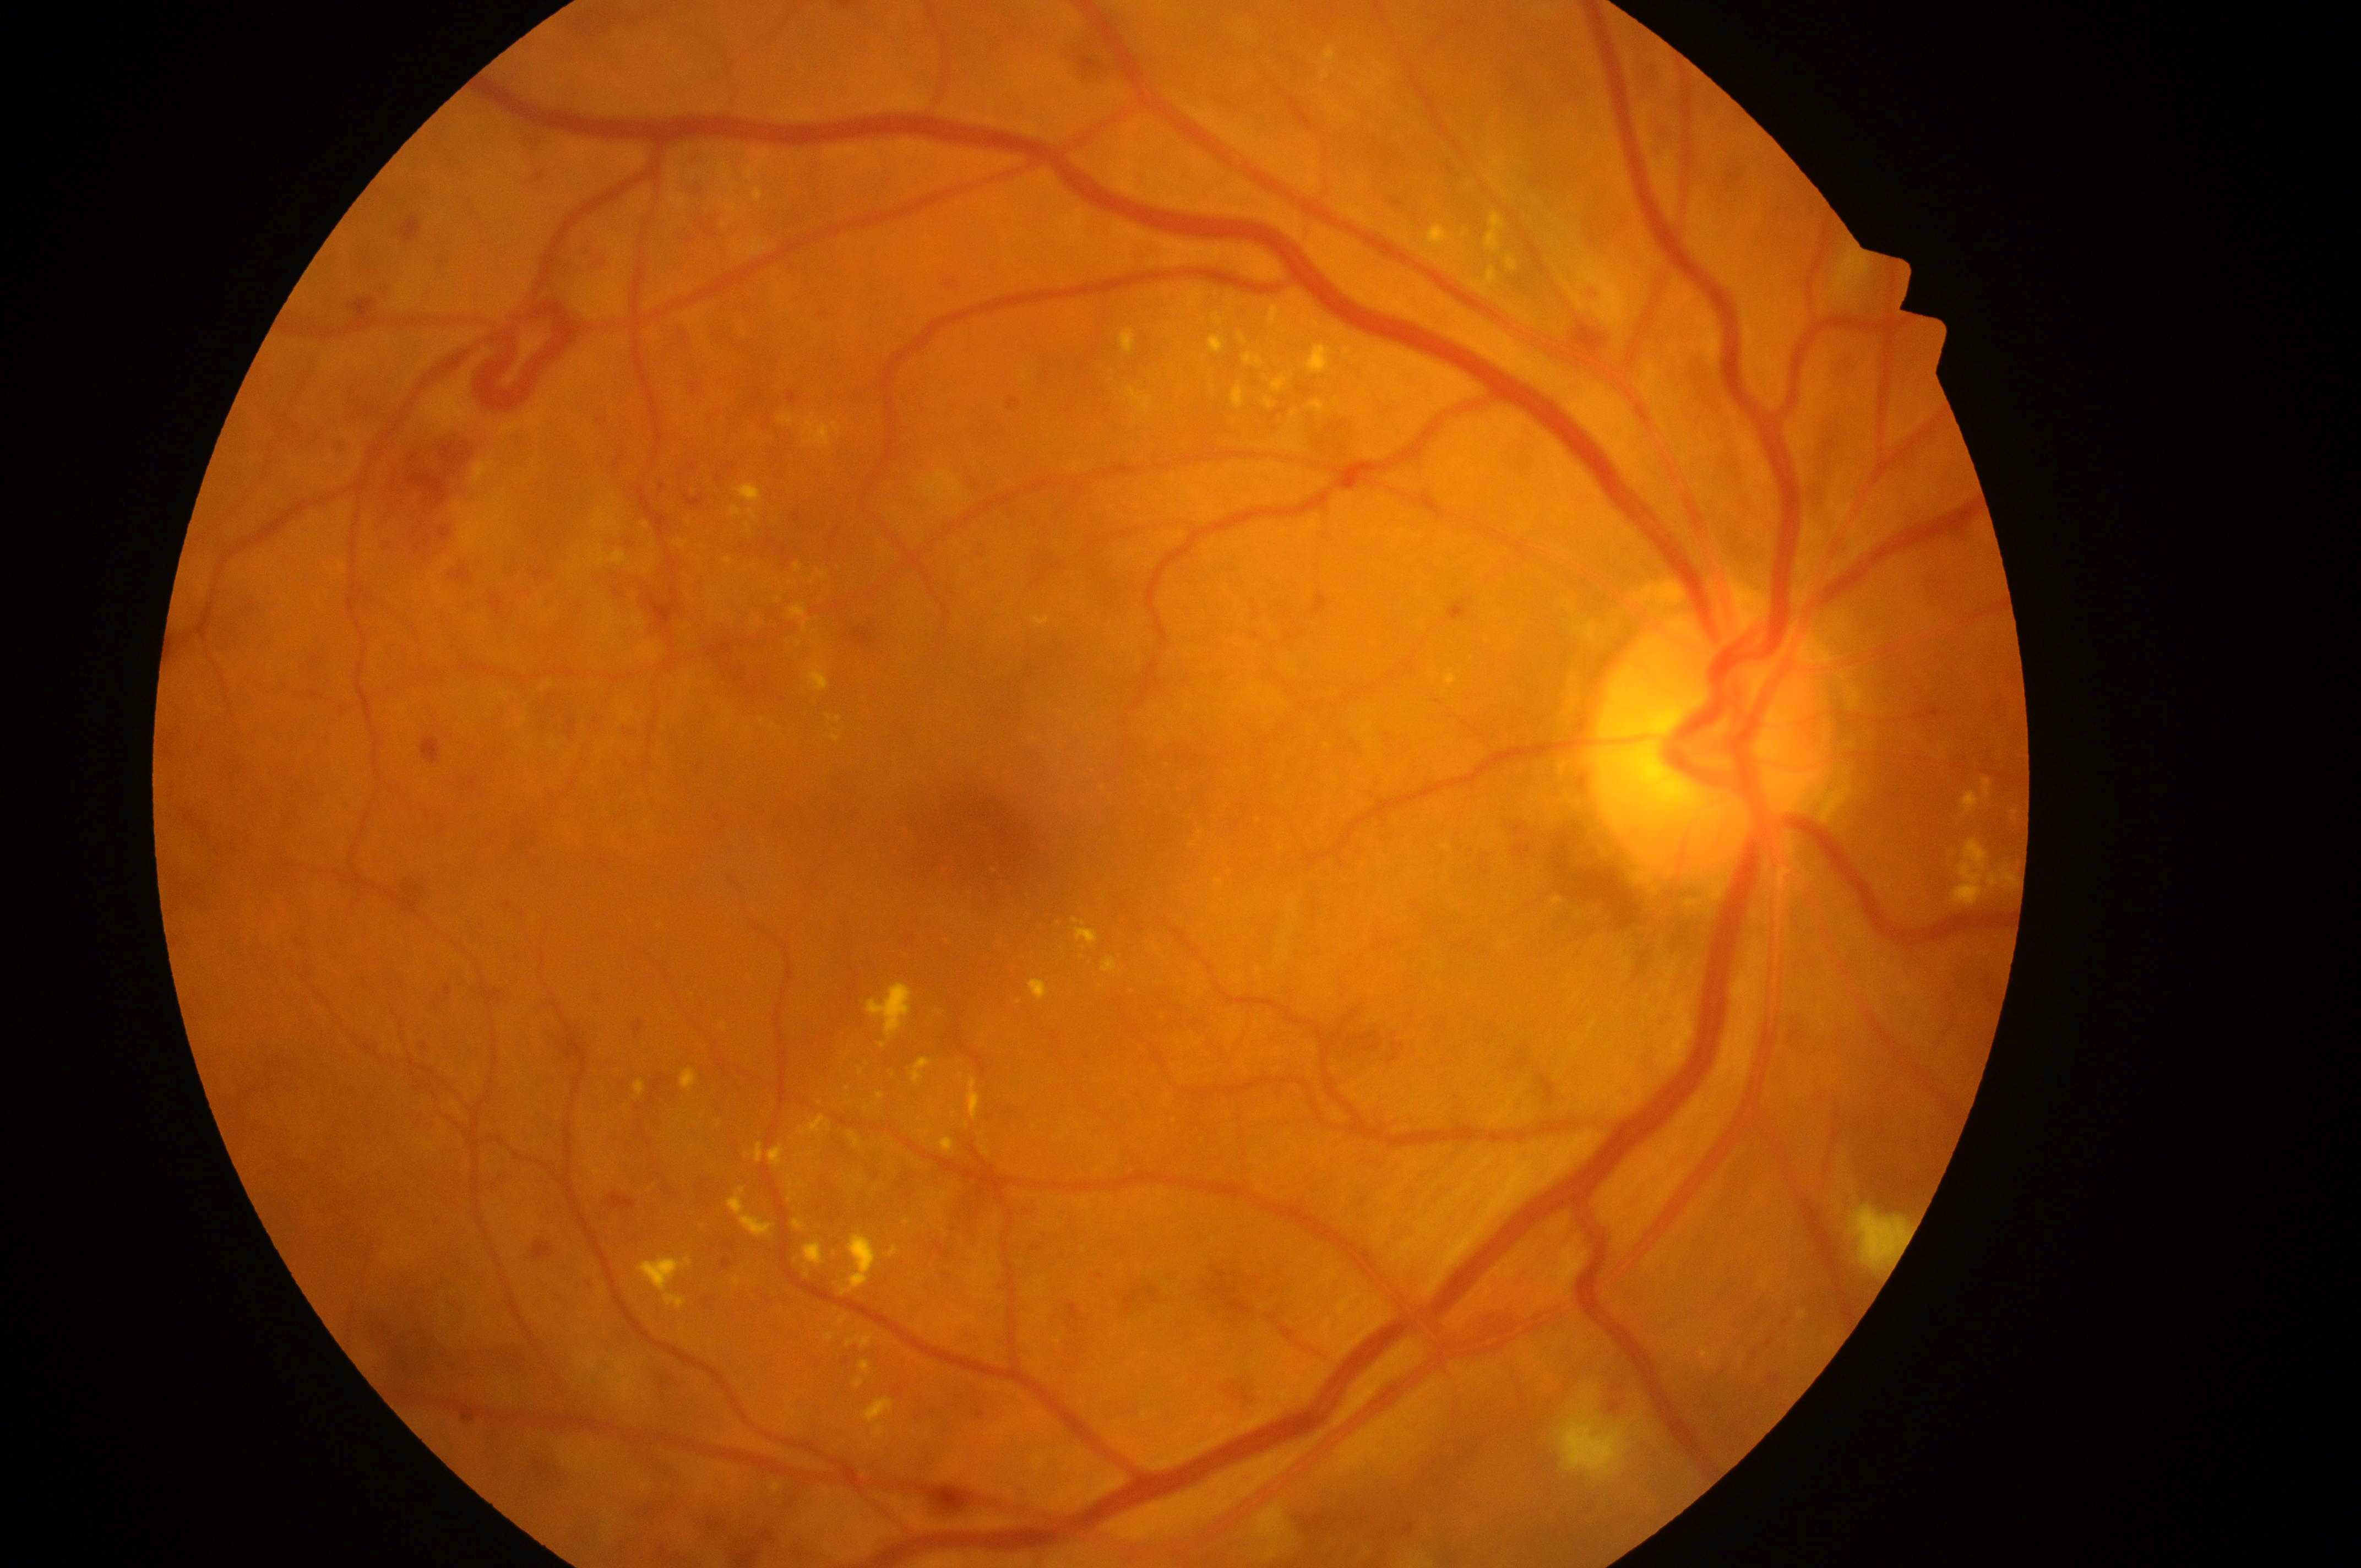

macular center: [992, 843]
diabetic retinopathy (DR): 3/4 — more than 20 intraretinal hemorrhages in each of 4 quadrants, definite venous beading in 2 or more quadrants, or prominent intraretinal microvascular abnormalities in 1 or more quadrants, with no signs of proliferative retinopathy
laterality: right
diabetic macular edema (DME): grade 2 — hard exudates within one disc diameter of the macula center
disc center: [1708, 750]